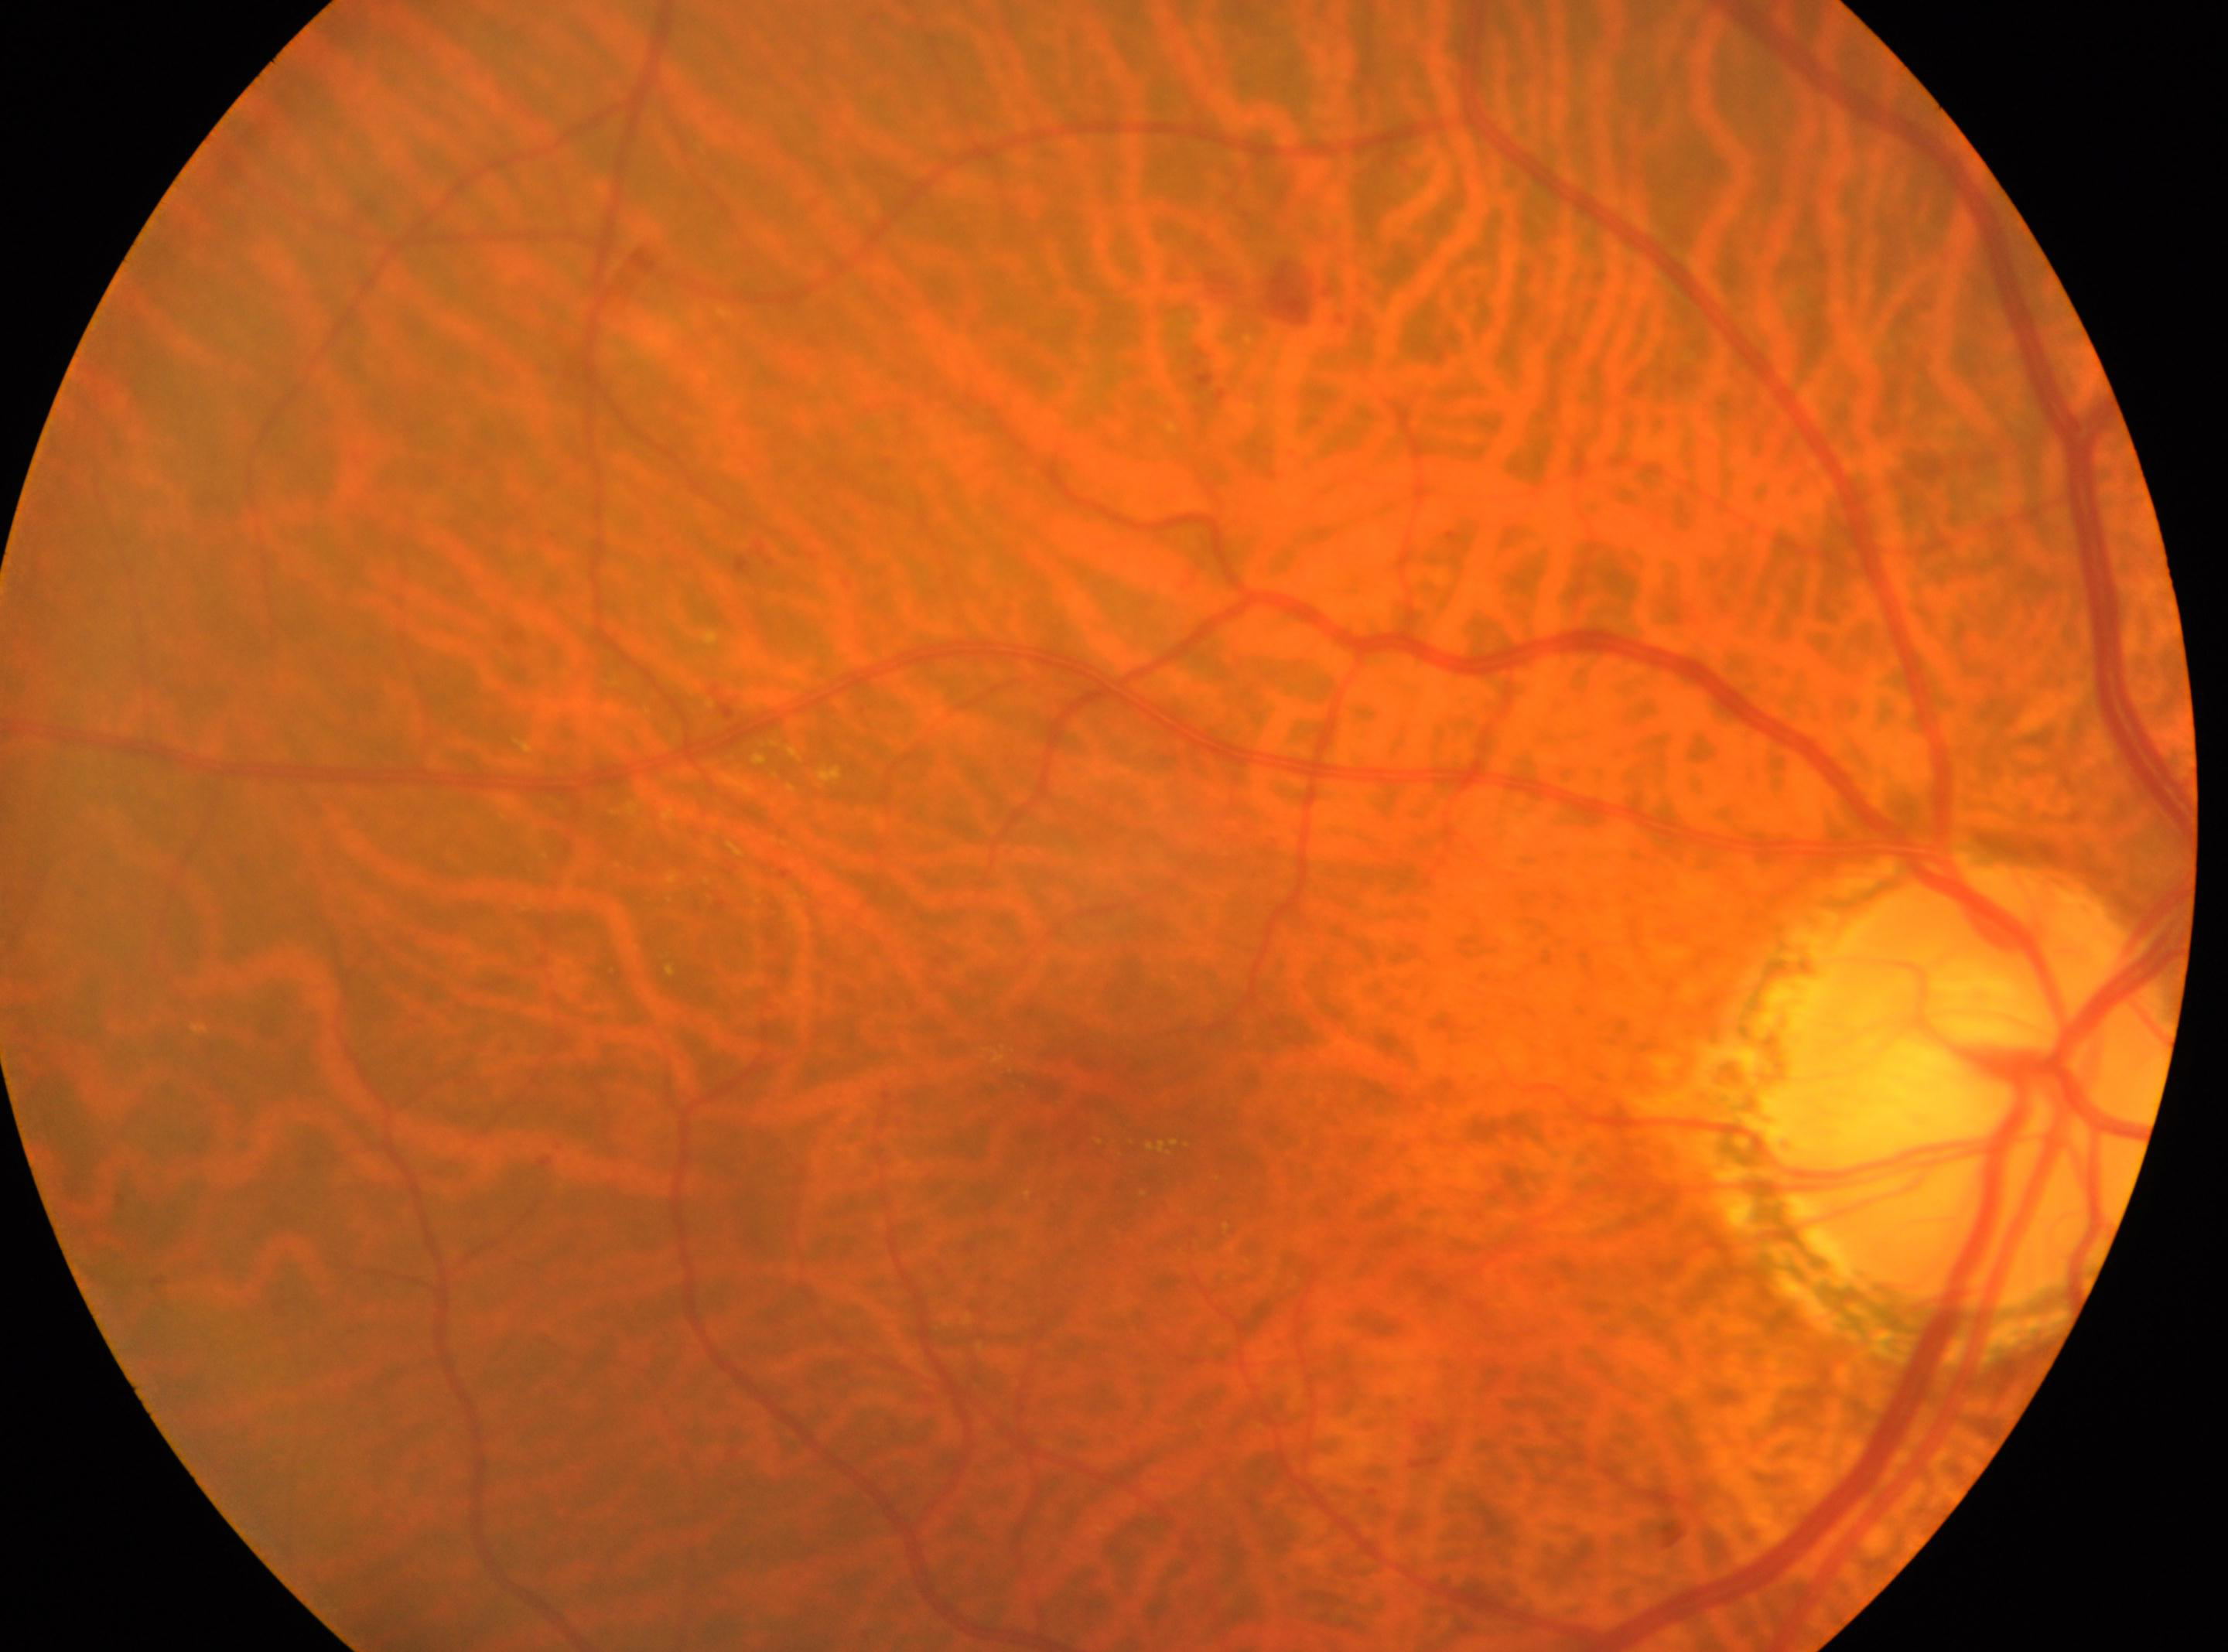
Fovea center located at (1116,1097). Optic nerve head: (1971,1087). Diabetic retinopathy (DR) is 2/4. The image shows the OD.